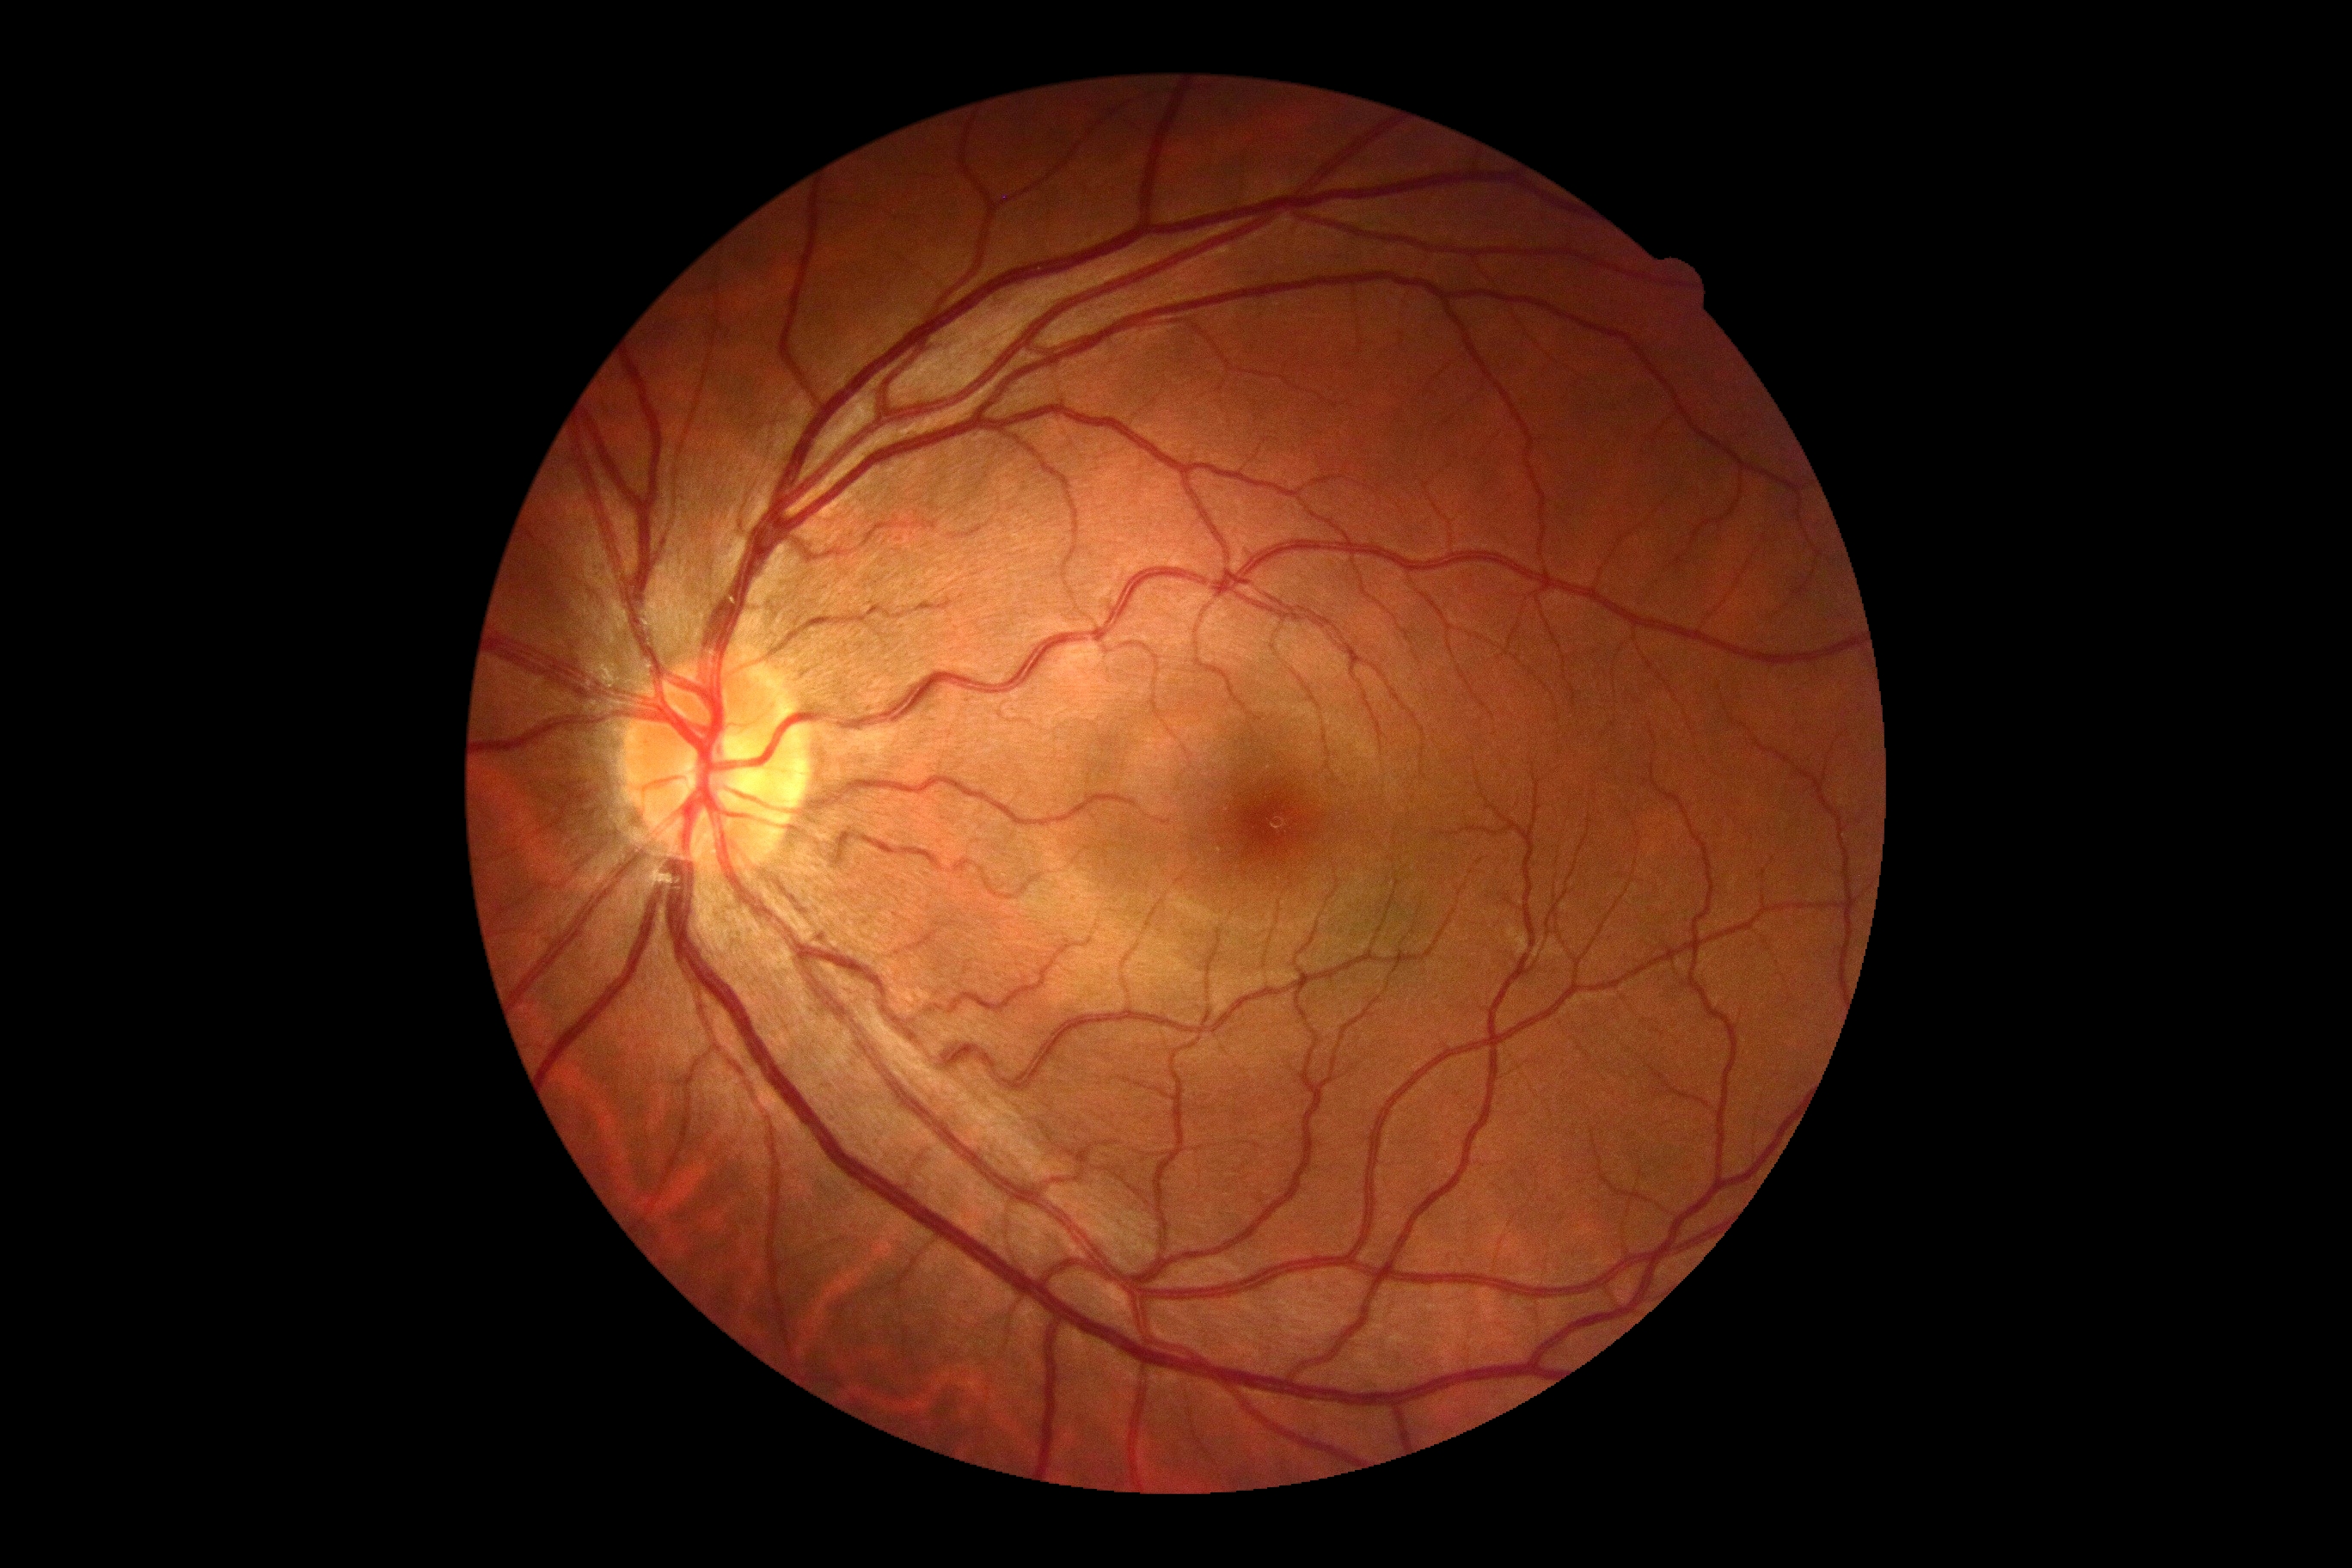

DR impression = no apparent DR
DR grade = 0